FOV: 50 degrees; macula at the center of the field.
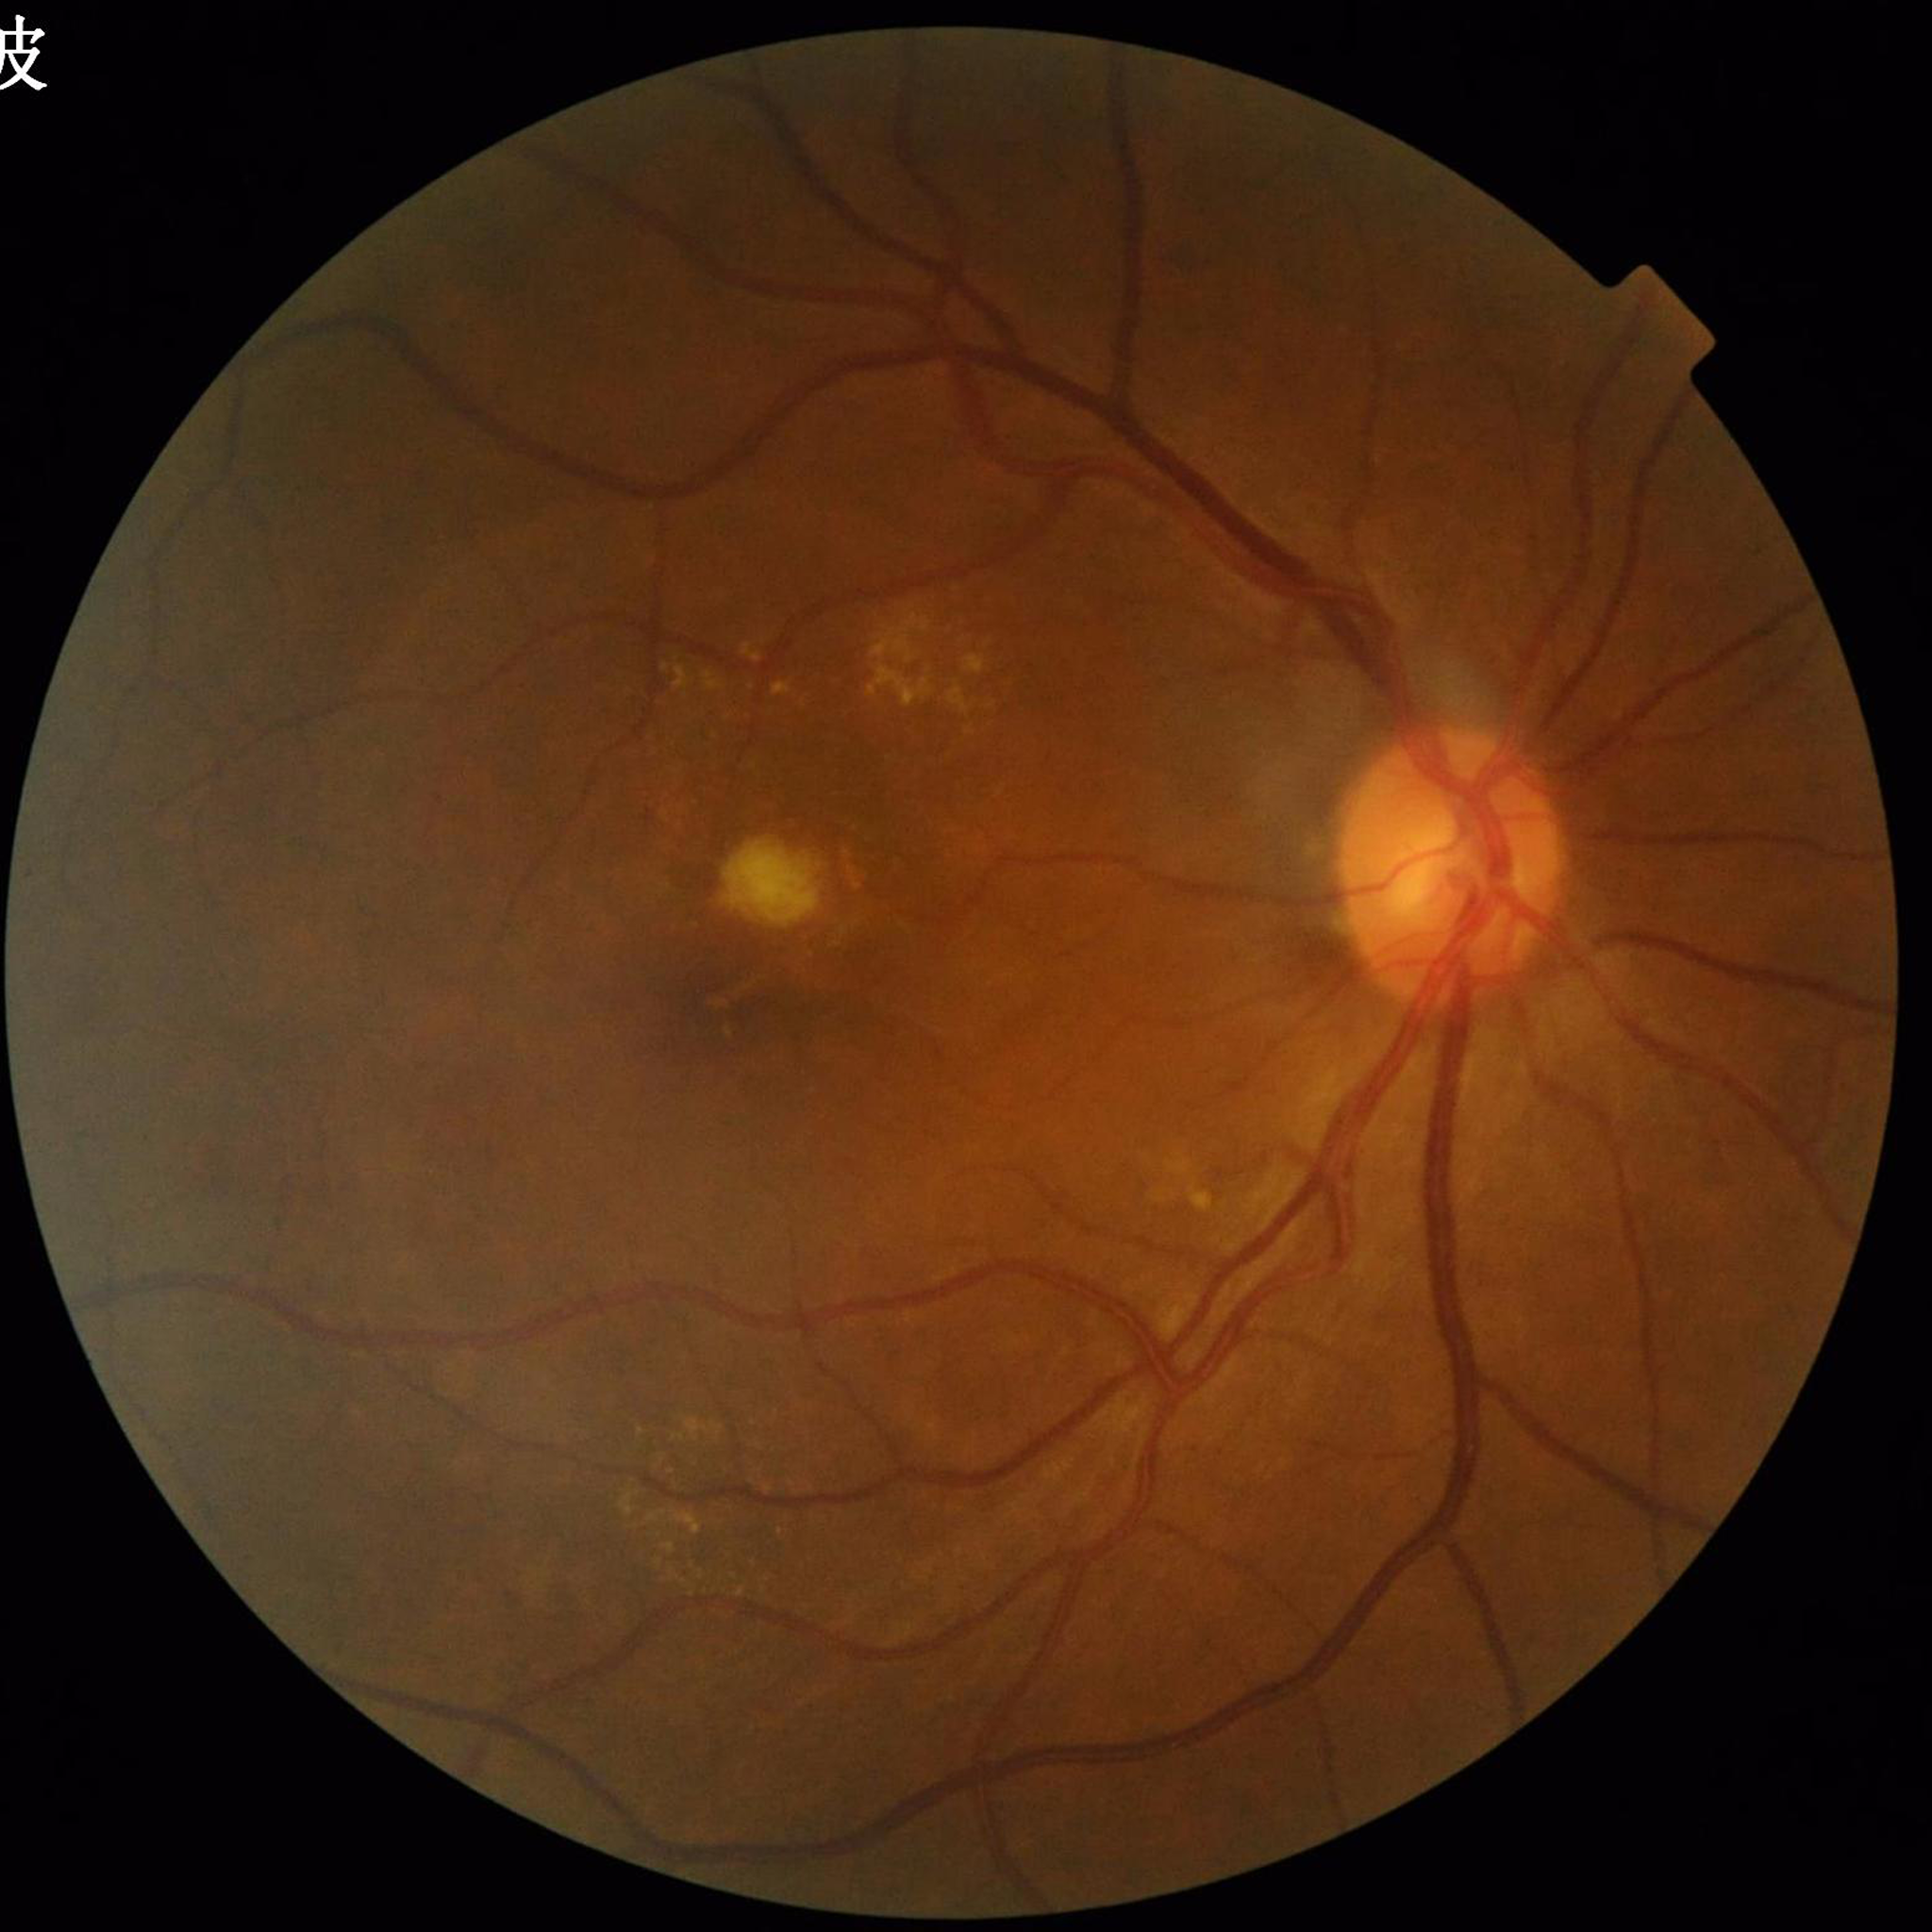
Condition: age-related macular degeneration.